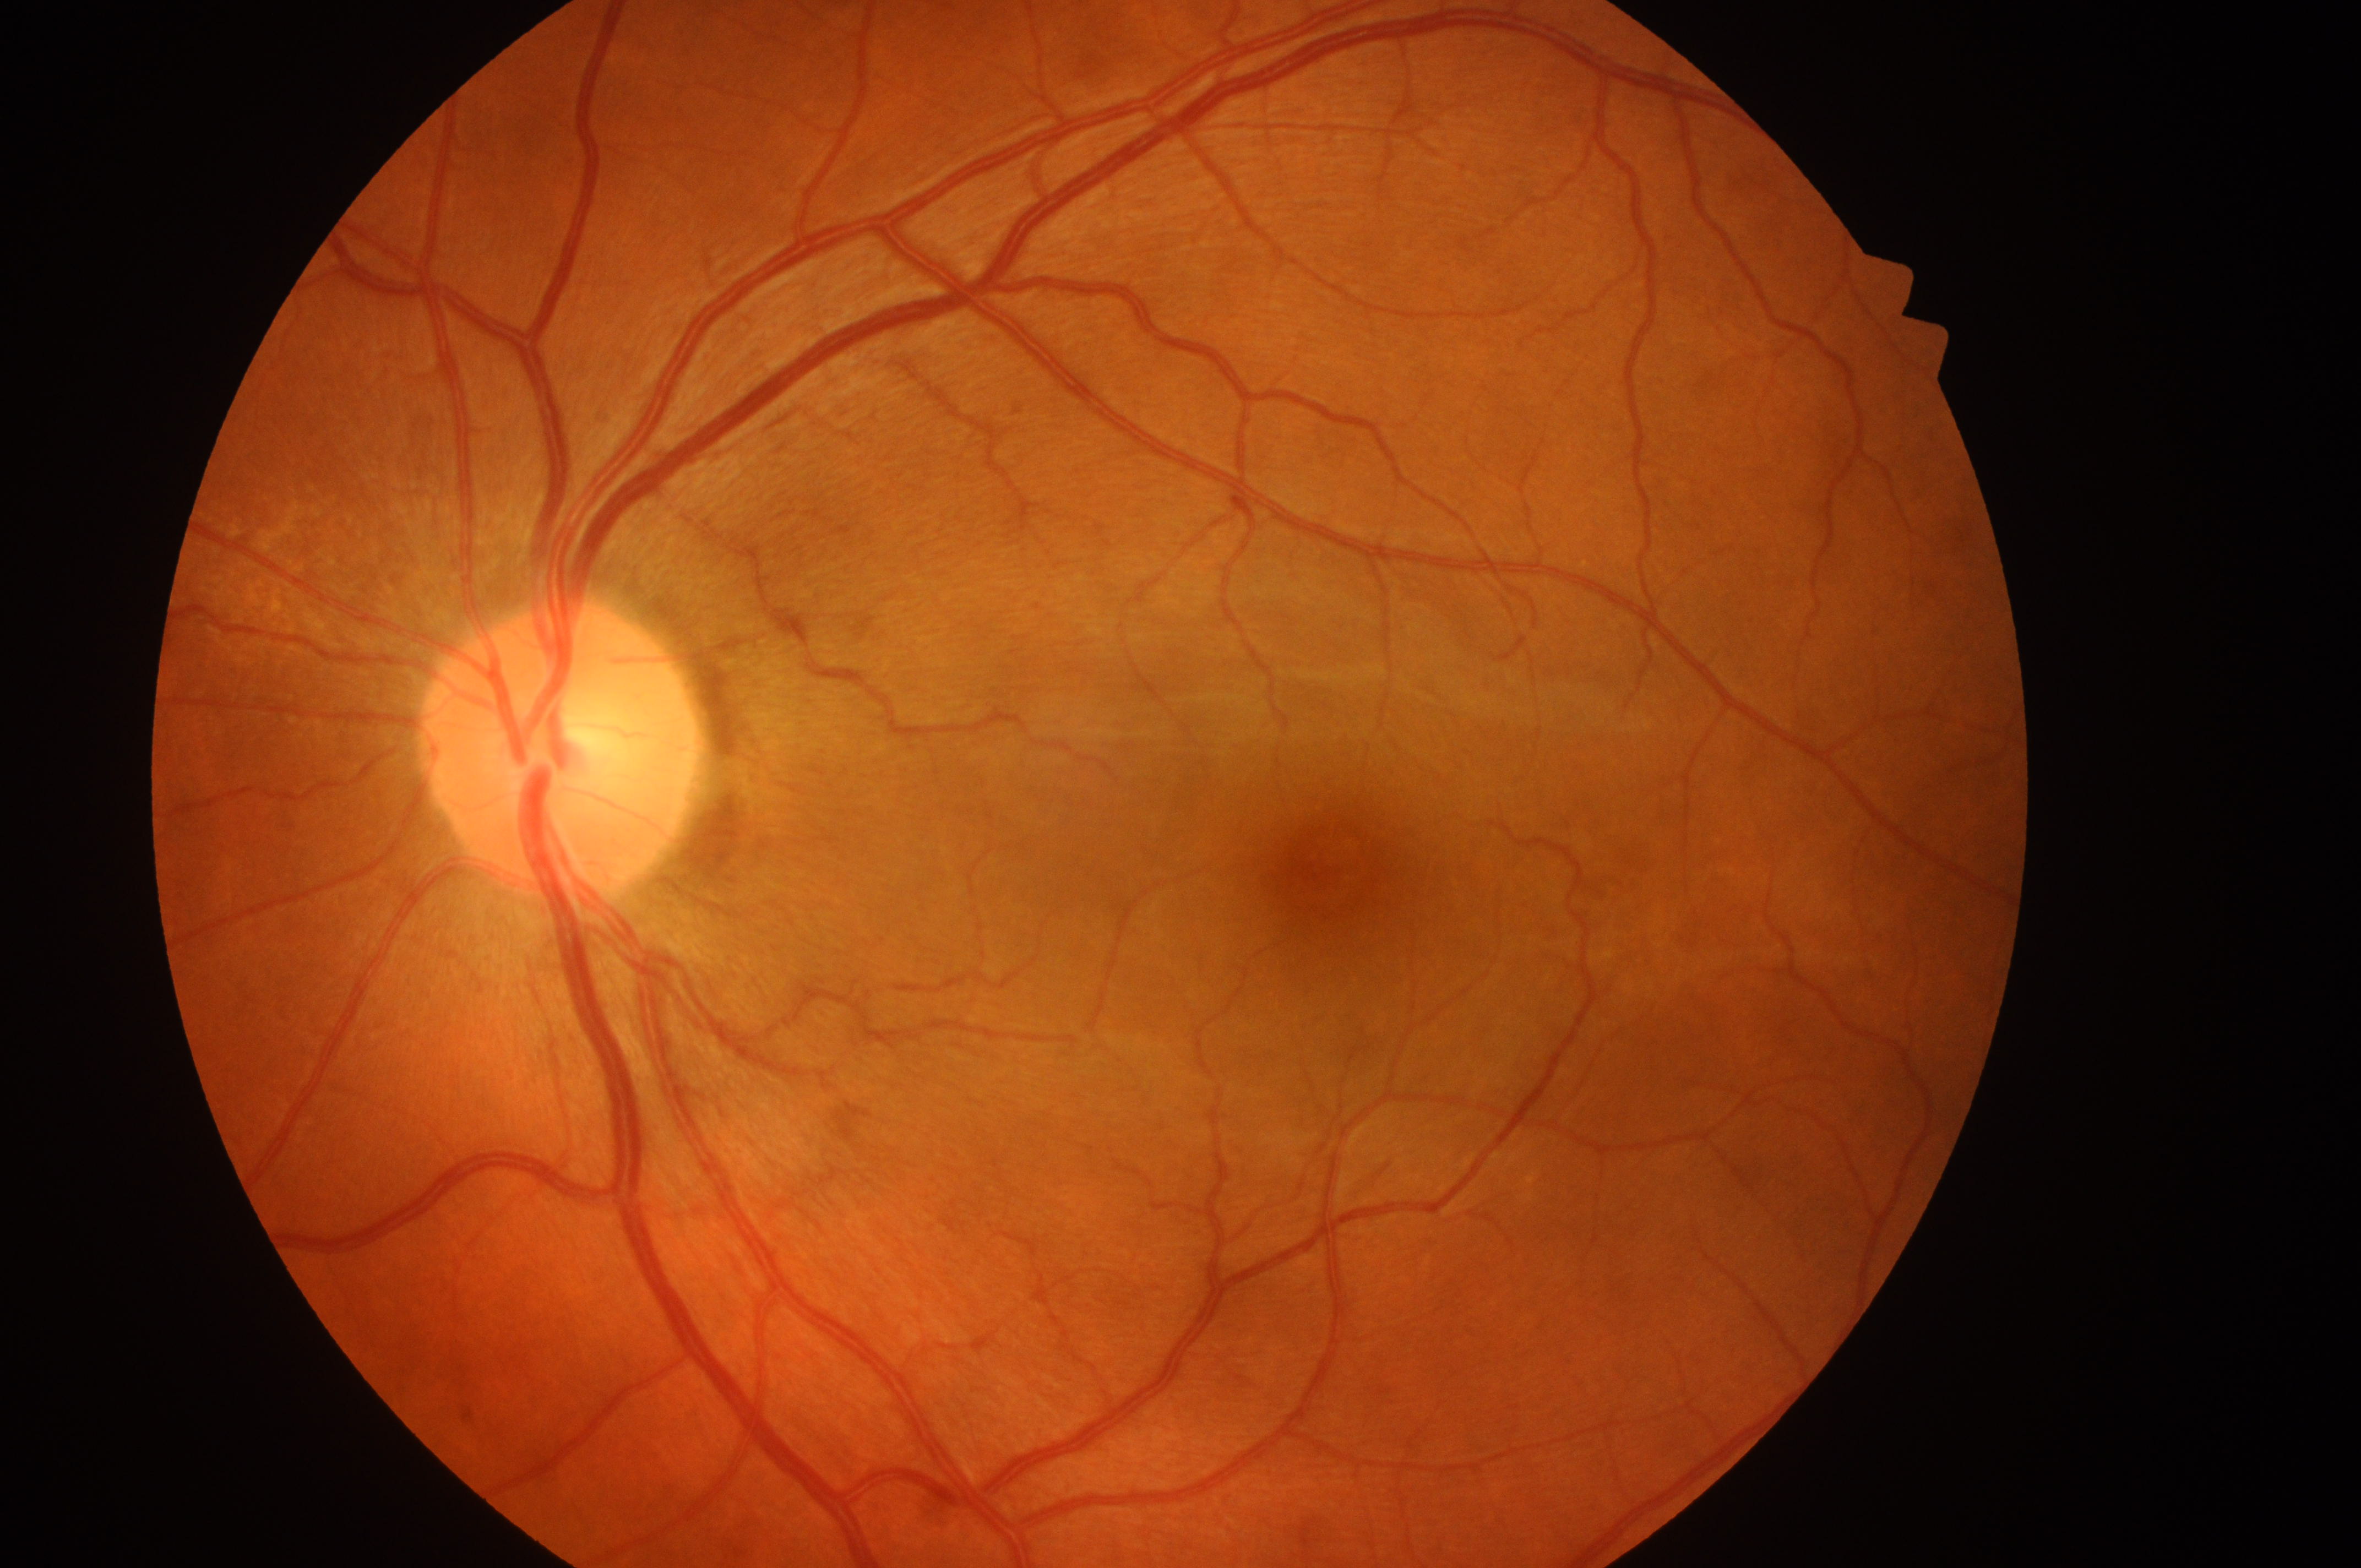 Optic disk: x=554, y=760.
The fovea center is at x=1335, y=874.
Eye: OS.
DME grade: 0.
DR grade is 0.